No pharmacologic dilation — 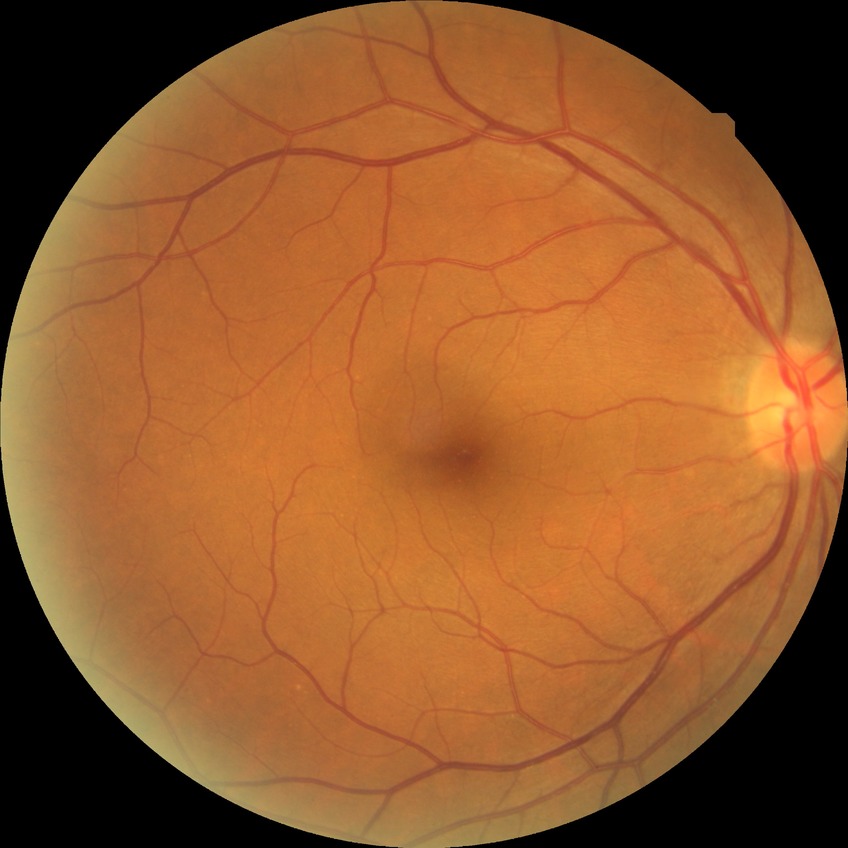 diabetic retinopathy (DR): NDR (no diabetic retinopathy).